CFP — 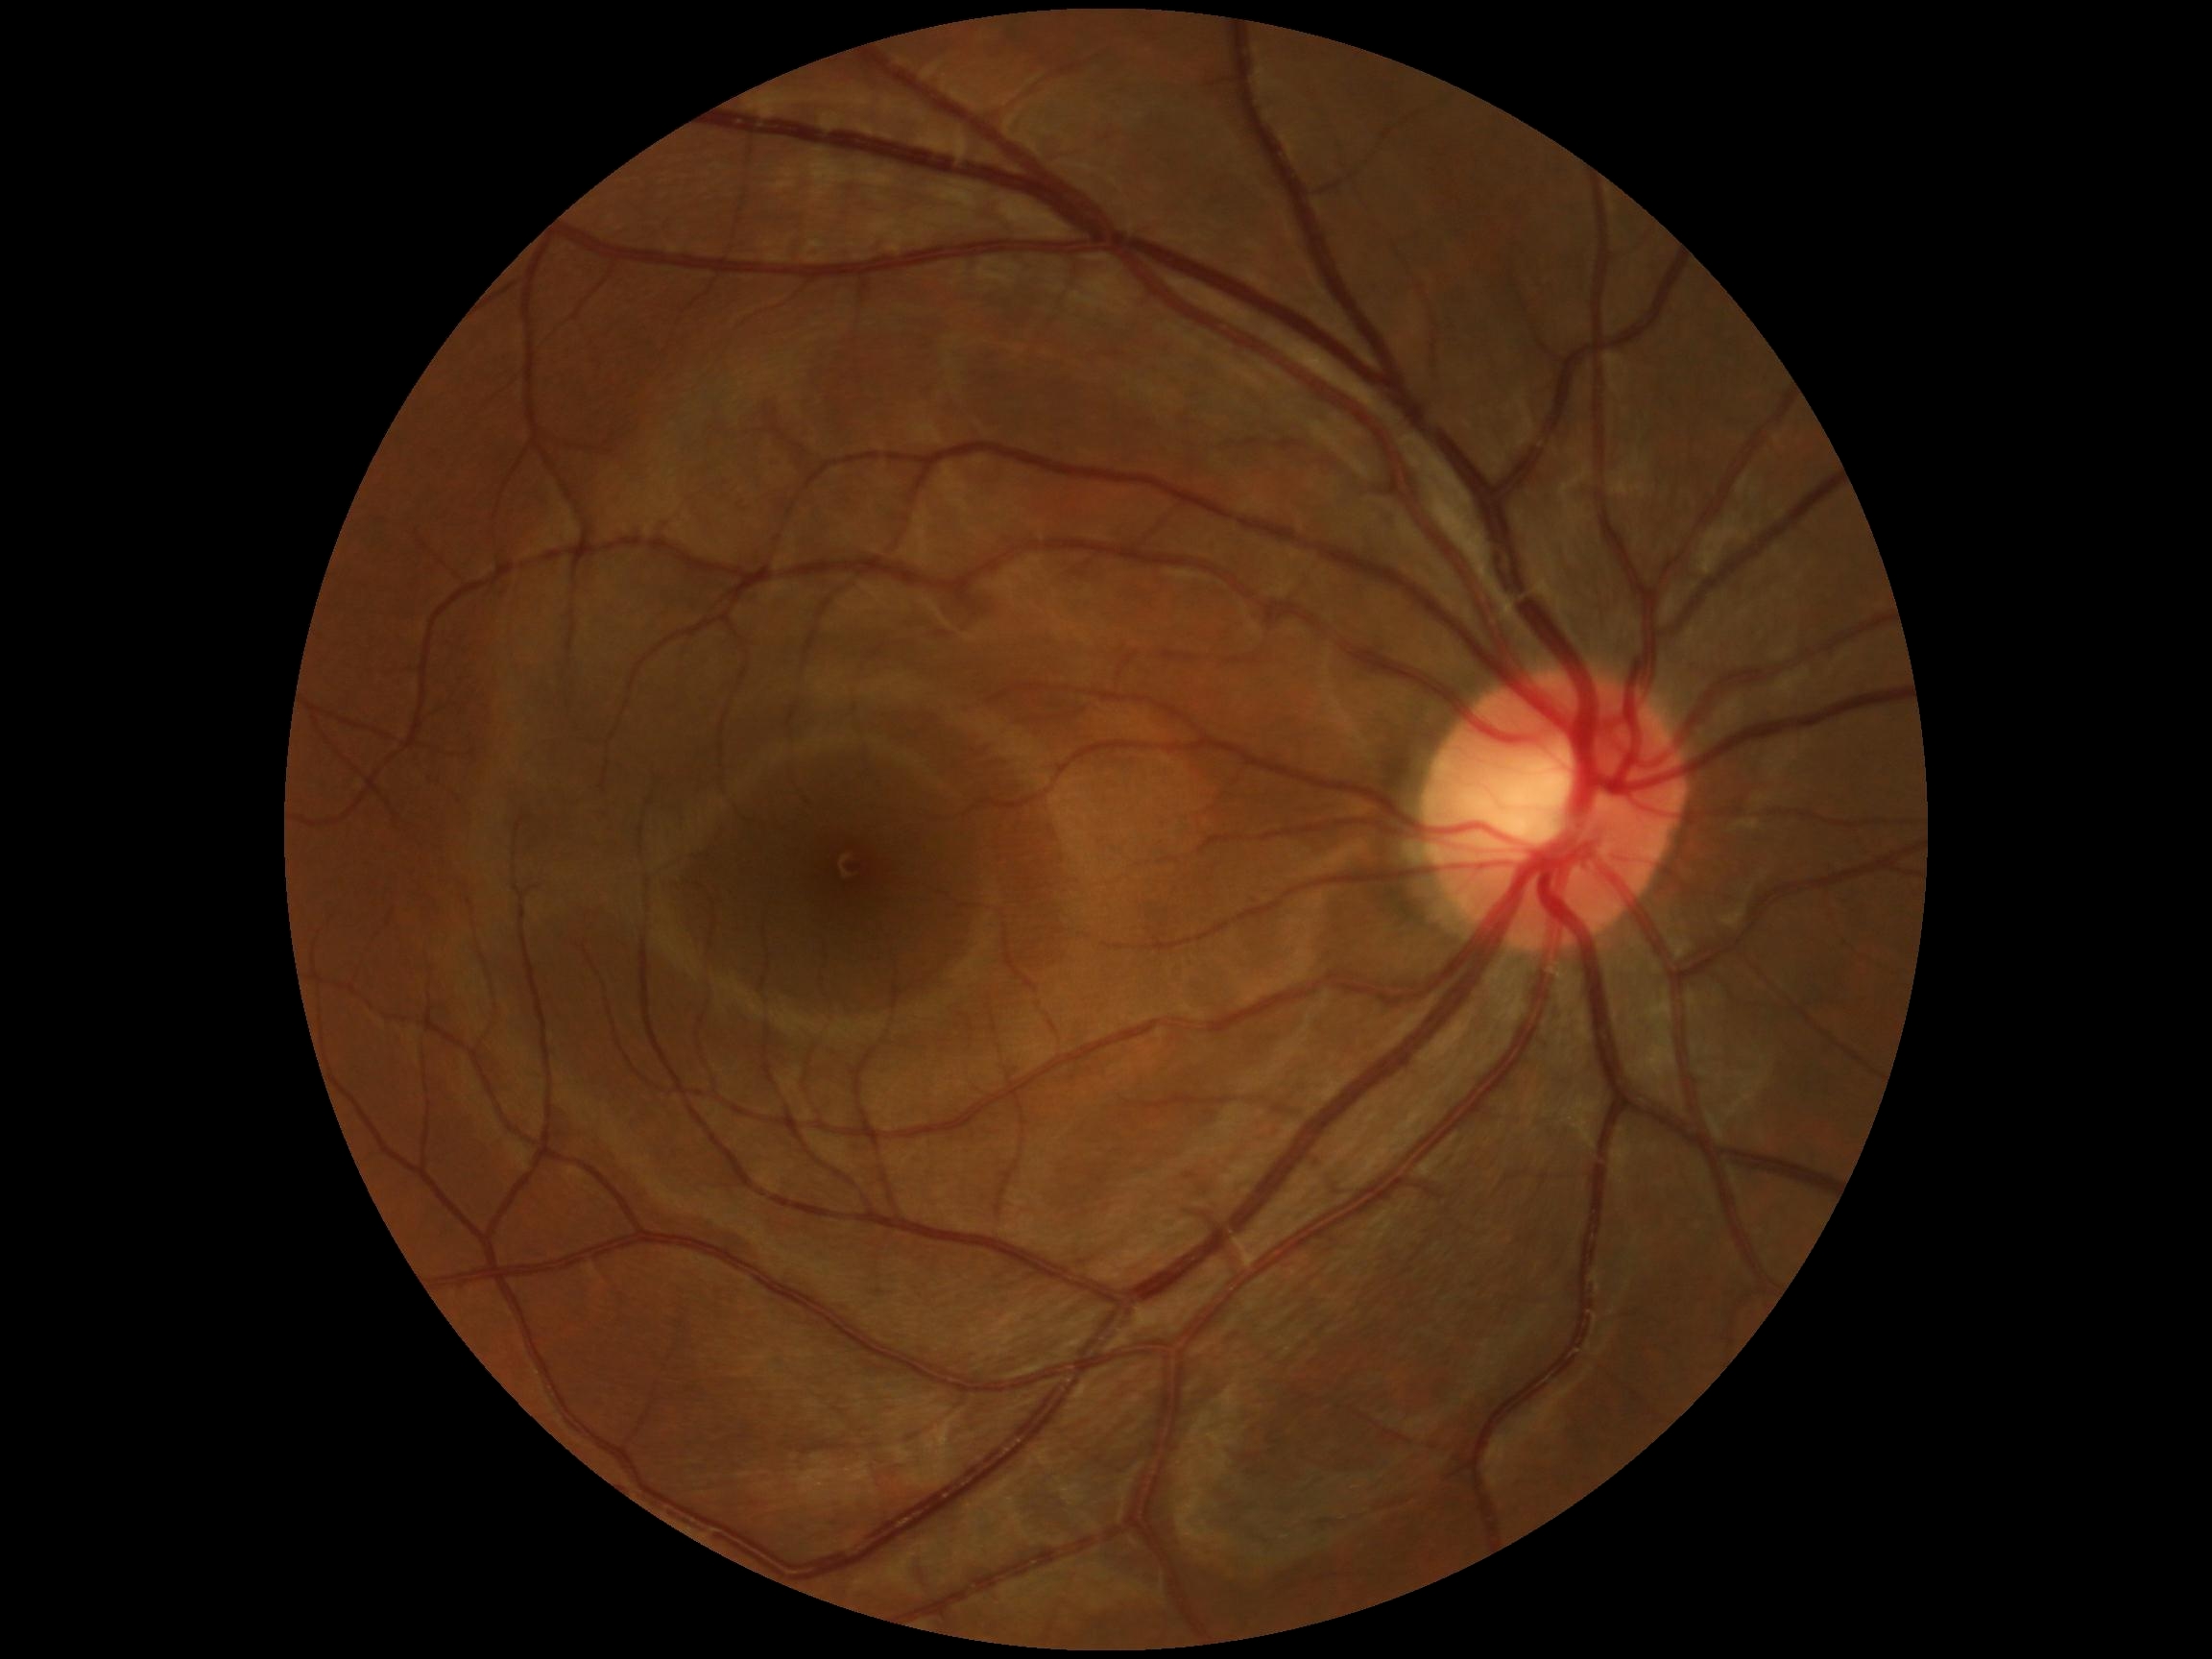
{
  "dr_impression": "negative for DR",
  "dr_grade": "grade 0 — no visible signs of diabetic retinopathy"
}